RetCam wide-field infant fundus image · acquired on the Natus RetCam Envision:
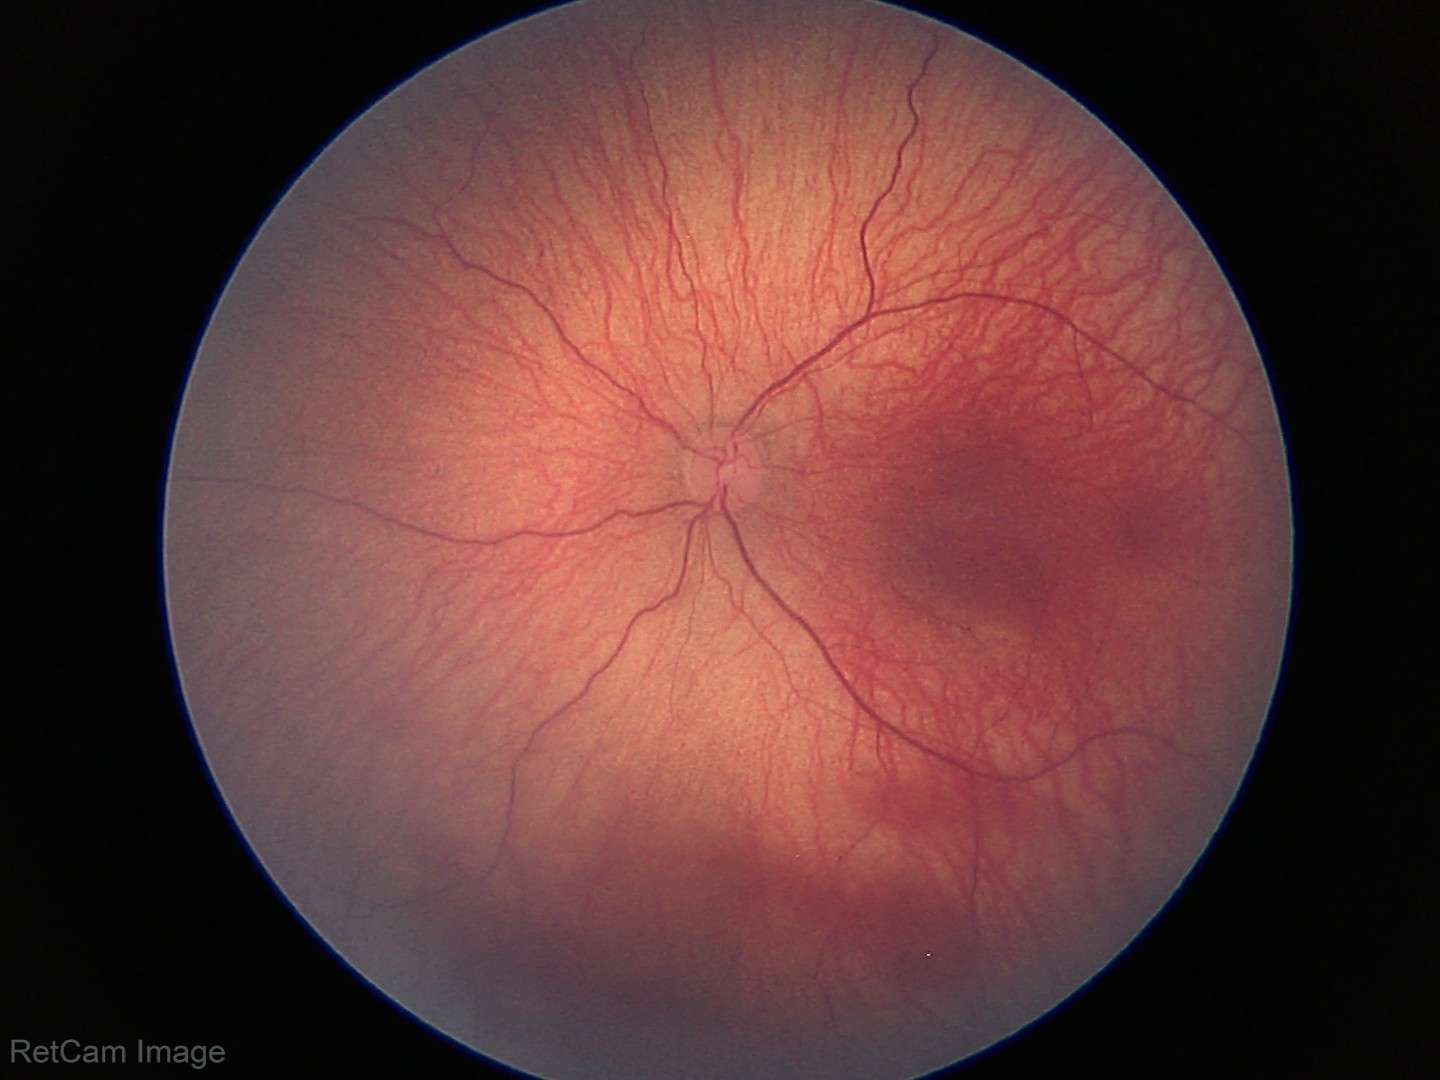

Without plus disease.
Diagnosis from this screening exam: retinopathy of prematurity (ROP) stage 1.